45 degree fundus photograph.
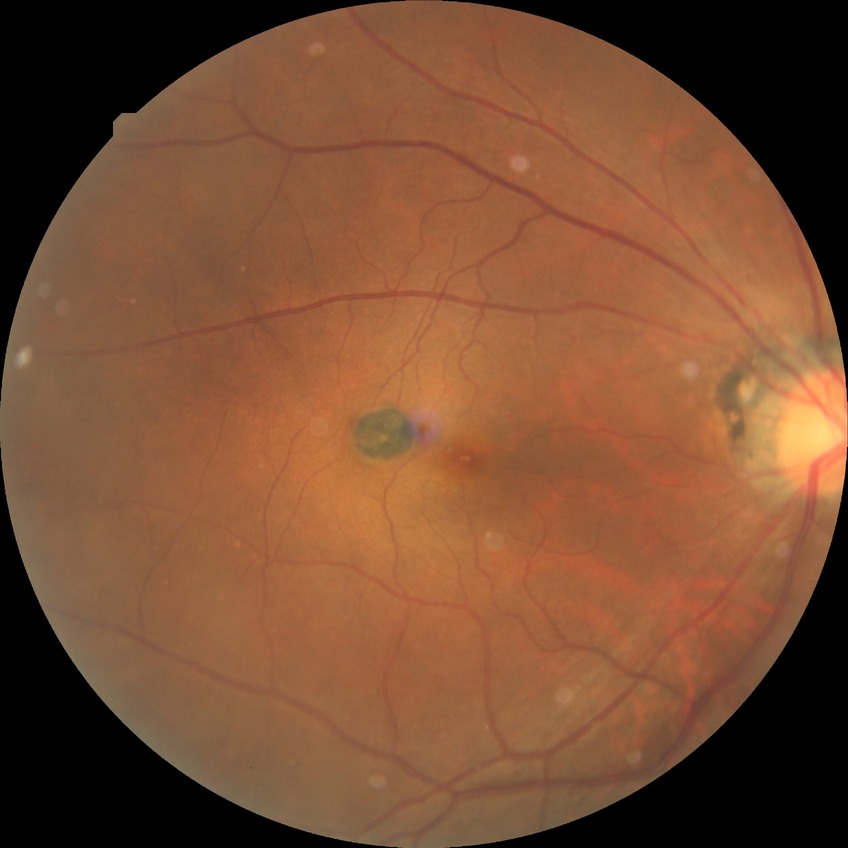 DR impression = no DR findings
Davis stage = NDR